Color fundus photograph, FOV: 45 degrees.
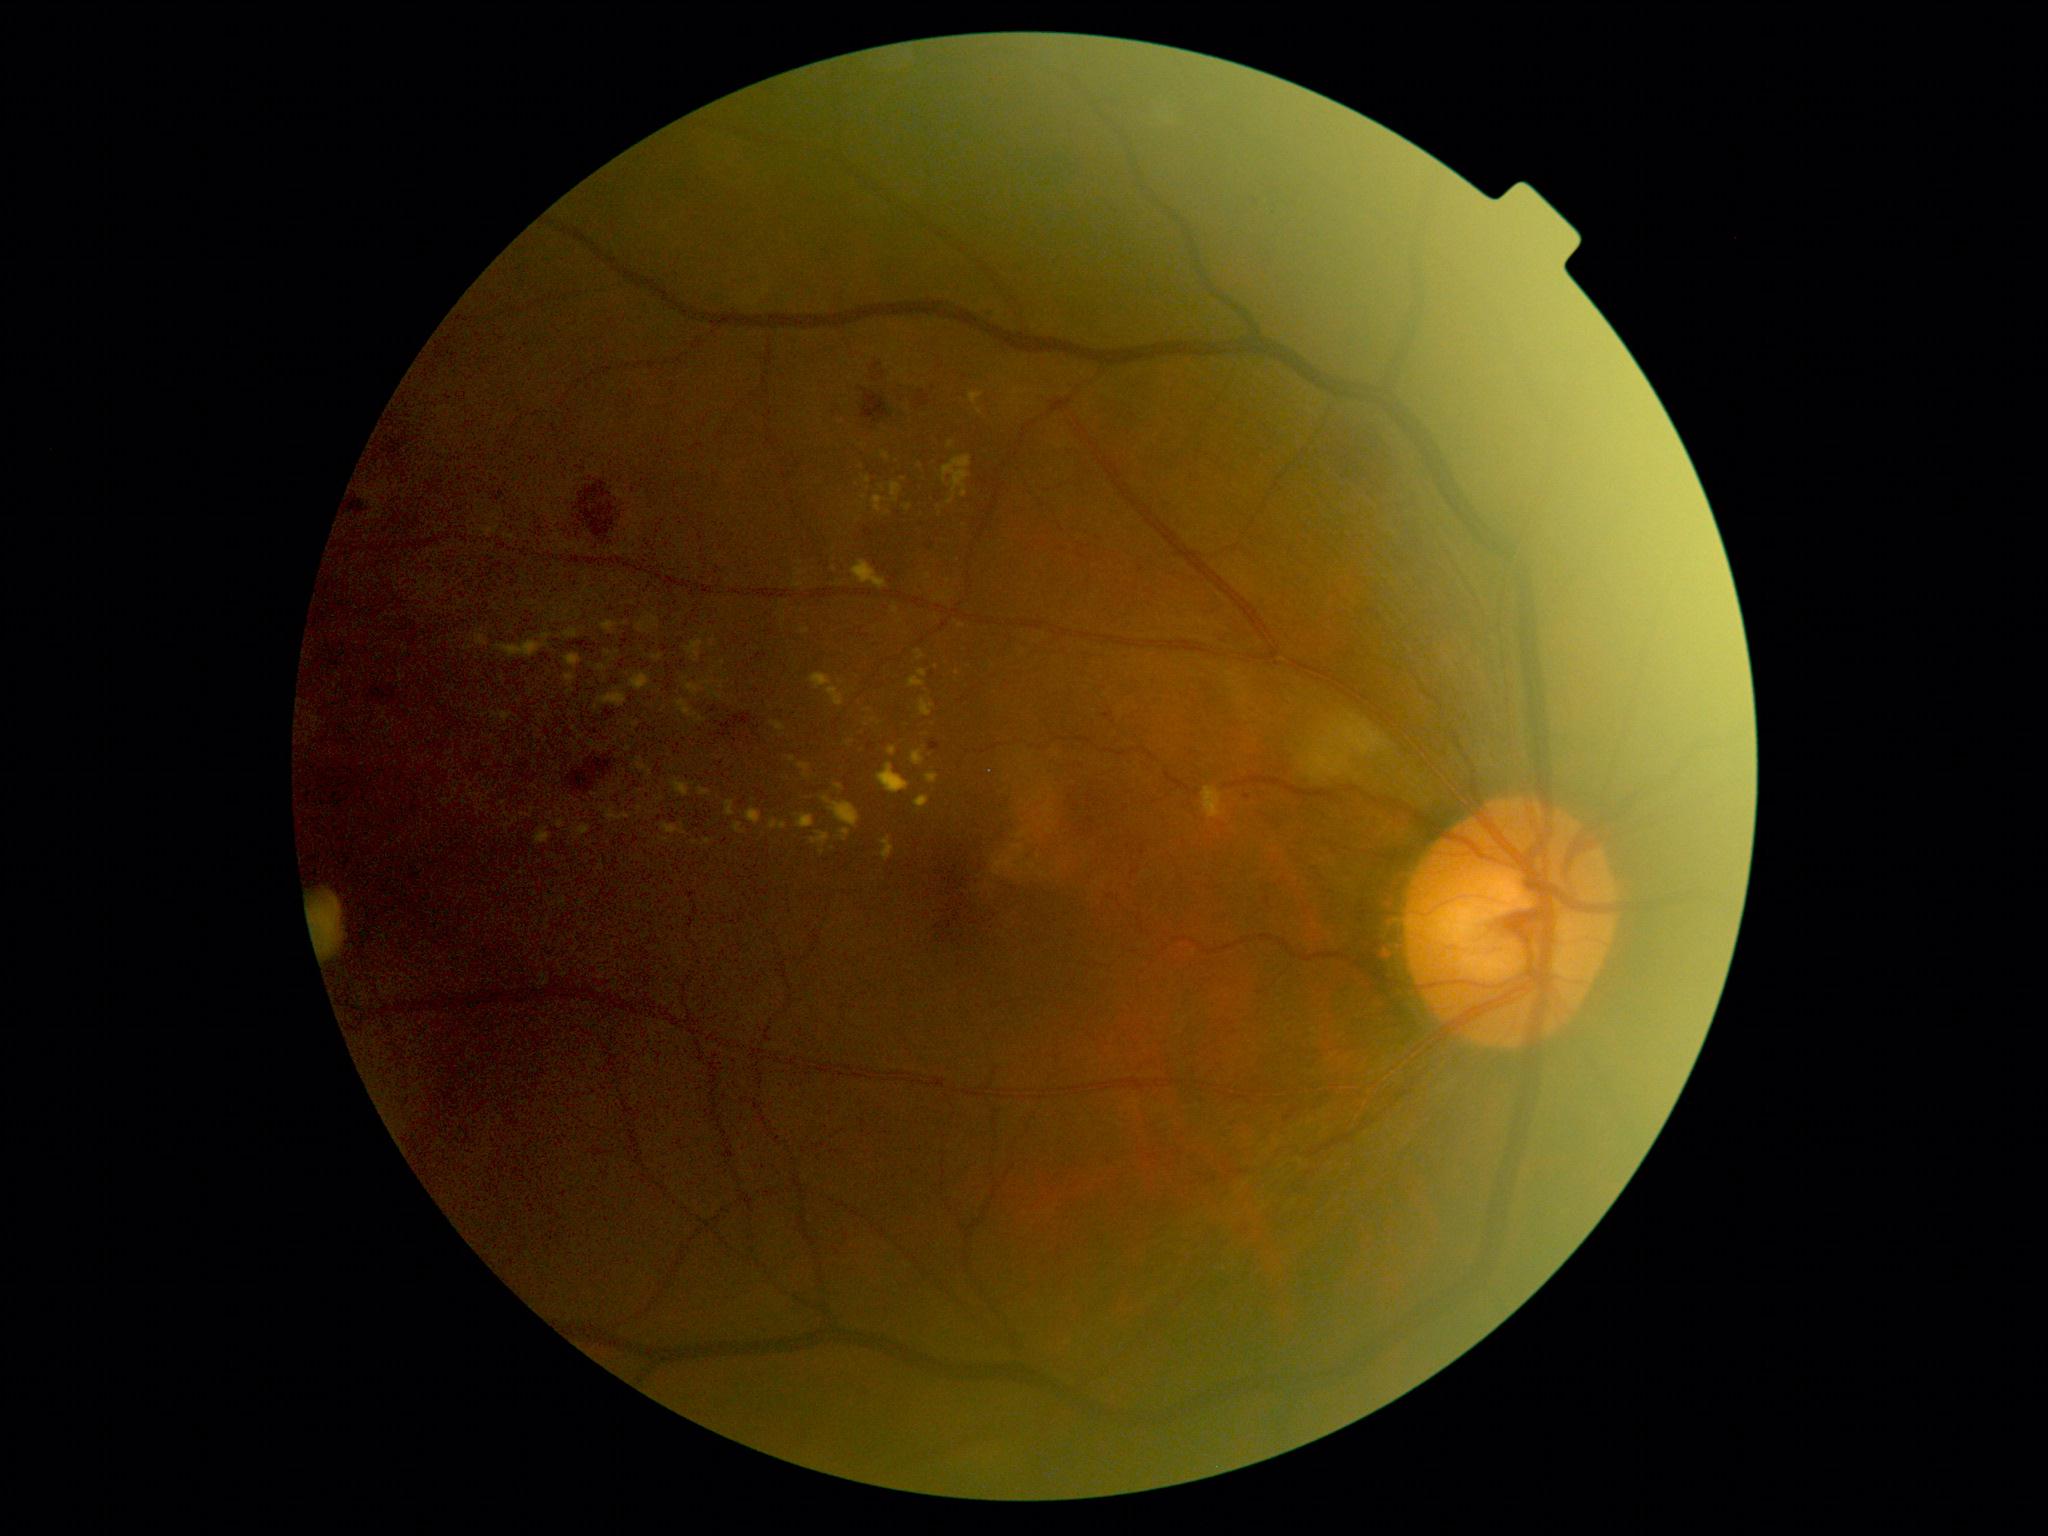 Diabetic retinopathy (DR) is 2/4; non-proliferative diabetic retinopathy
Selected lesions:
hard exudates (EXs) (subset): {"left": 689, "top": 642, "right": 703, "bottom": 653}; {"left": 944, "top": 457, "right": 971, "bottom": 492}; {"left": 498, "top": 642, "right": 542, "bottom": 658}; {"left": 798, "top": 816, "right": 814, "bottom": 829}; {"left": 606, "top": 812, "right": 629, "bottom": 820}; {"left": 664, "top": 825, "right": 678, "bottom": 835}; {"left": 889, "top": 748, "right": 896, "bottom": 756}; {"left": 971, "top": 394, "right": 981, "bottom": 403}; {"left": 566, "top": 675, "right": 575, "bottom": 683}; {"left": 828, "top": 688, "right": 843, "bottom": 707}; {"left": 604, "top": 622, "right": 615, "bottom": 632}
EXs (small, approximate centers) near Point(580, 738); Point(593, 744); Point(846, 833); Point(827, 800); Point(868, 480)
soft exudates (SEs): {"left": 1294, "top": 724, "right": 1383, "bottom": 783}
hemorrhages (HEs): {"left": 869, "top": 364, "right": 887, "bottom": 382}; {"left": 916, "top": 391, "right": 932, "bottom": 408}; {"left": 349, "top": 502, "right": 364, "bottom": 516}; {"left": 568, "top": 753, "right": 614, "bottom": 795}; {"left": 861, "top": 388, "right": 890, "bottom": 424}; {"left": 392, "top": 440, "right": 403, "bottom": 450}; {"left": 583, "top": 476, "right": 617, "bottom": 535}; {"left": 388, "top": 446, "right": 398, "bottom": 462}; {"left": 1328, "top": 423, "right": 1400, "bottom": 495}
microaneurysms (MAs): {"left": 1291, "top": 1108, "right": 1299, "bottom": 1114}; {"left": 1105, "top": 712, "right": 1114, "bottom": 721}; {"left": 493, "top": 491, "right": 504, "bottom": 502}; {"left": 864, "top": 528, "right": 874, "bottom": 538}; {"left": 931, "top": 741, "right": 941, "bottom": 751}
MAs (small, approximate centers) near Point(929, 549); Point(1256, 202); Point(986, 312); Point(1288, 1120); Point(1247, 797)